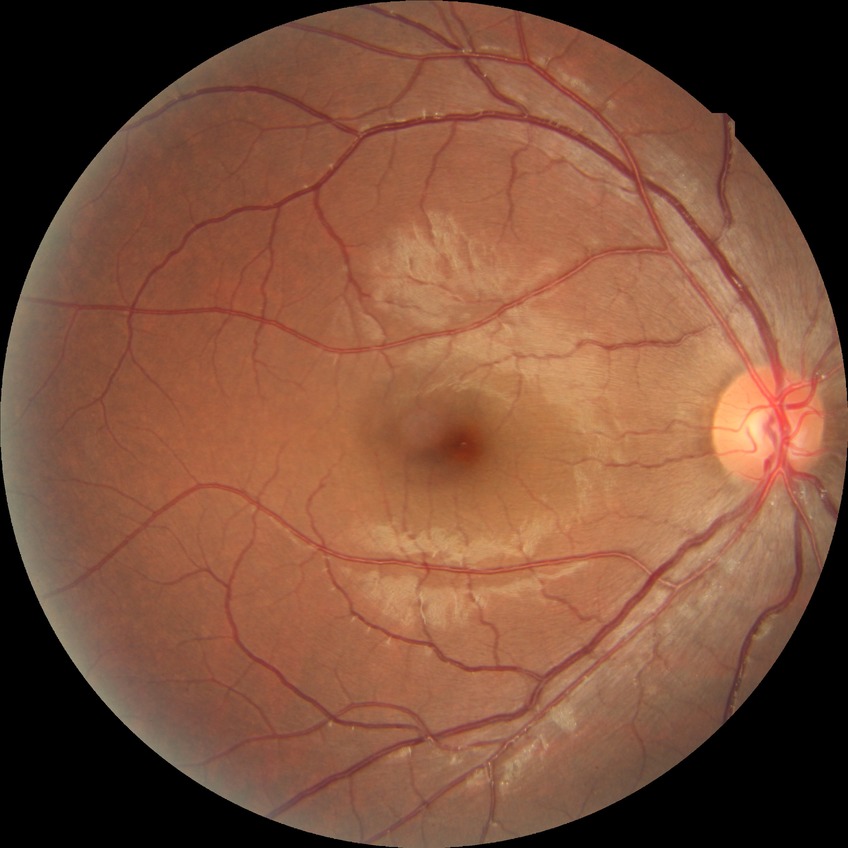 diabetic retinopathy (DR) = no diabetic retinopathy (NDR).